Wide-field retinal mosaic image; 200° field of view:
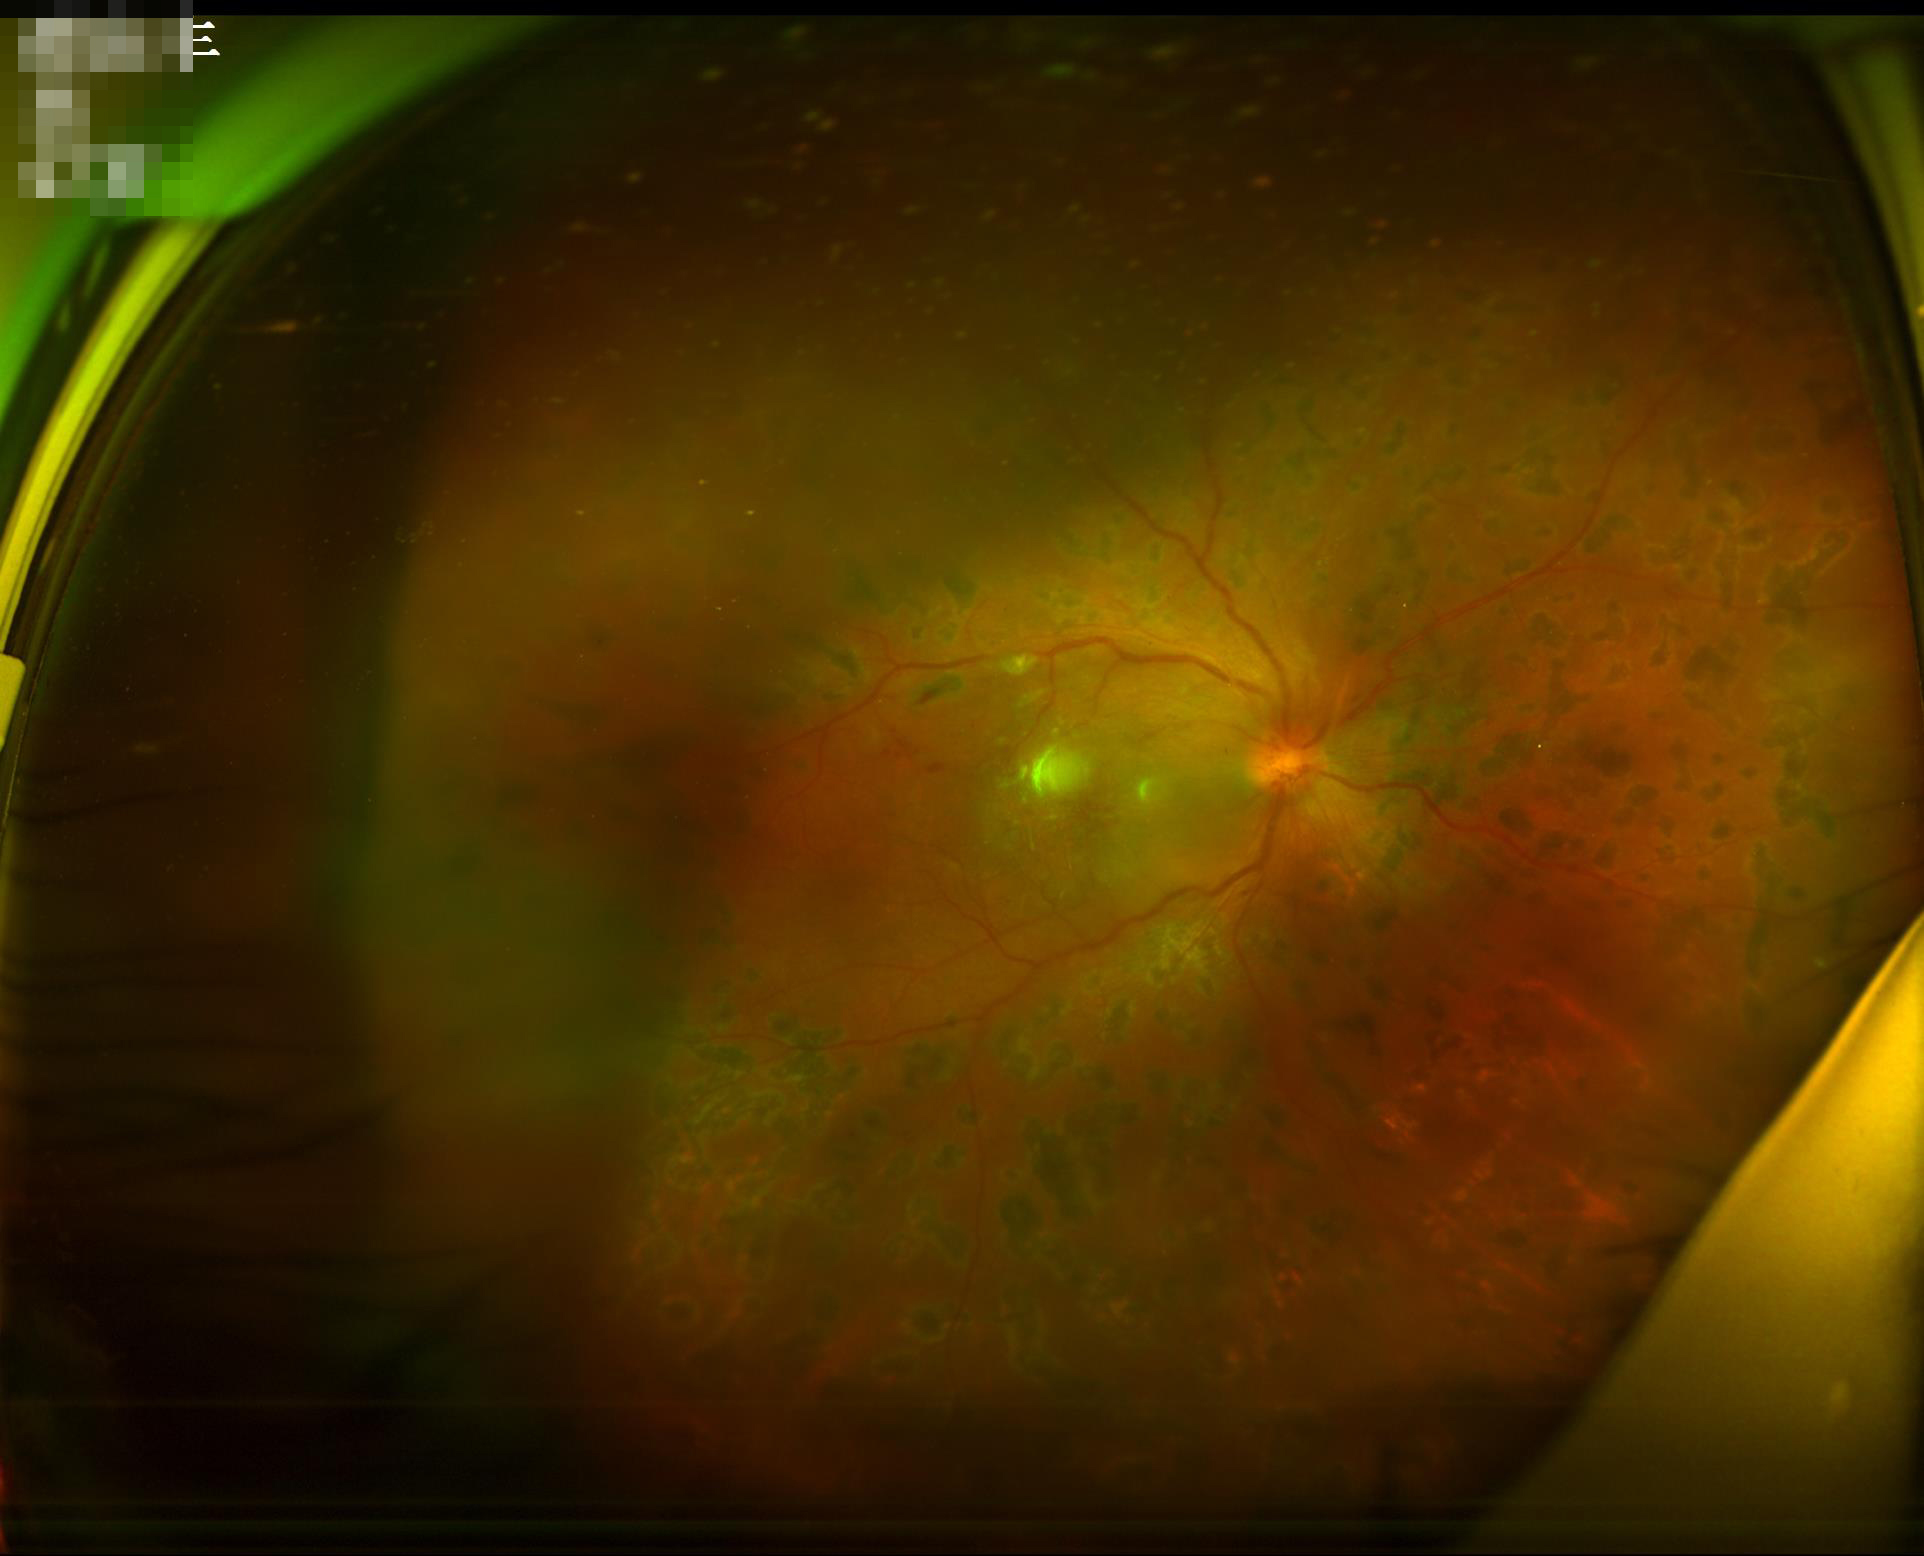

Illumination is uneven. Noticeable blur in the optic disc, vessels, or background. Vessels and details are readily distinguishable. Overall quality is poor; the image is difficult to grade.